45 degree fundus photograph — 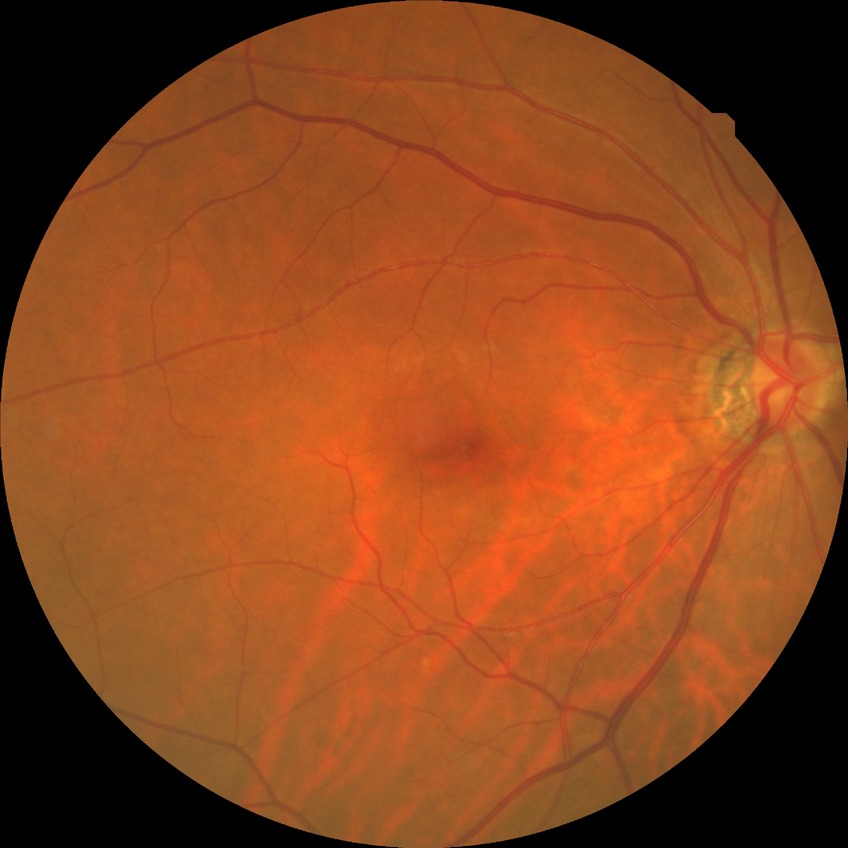

Modified Davis grade: NDR.
No signs of diabetic retinopathy.